Wide-field fundus photograph from neonatal ROP screening. Captured with the Phoenix ICON (100° field of view)
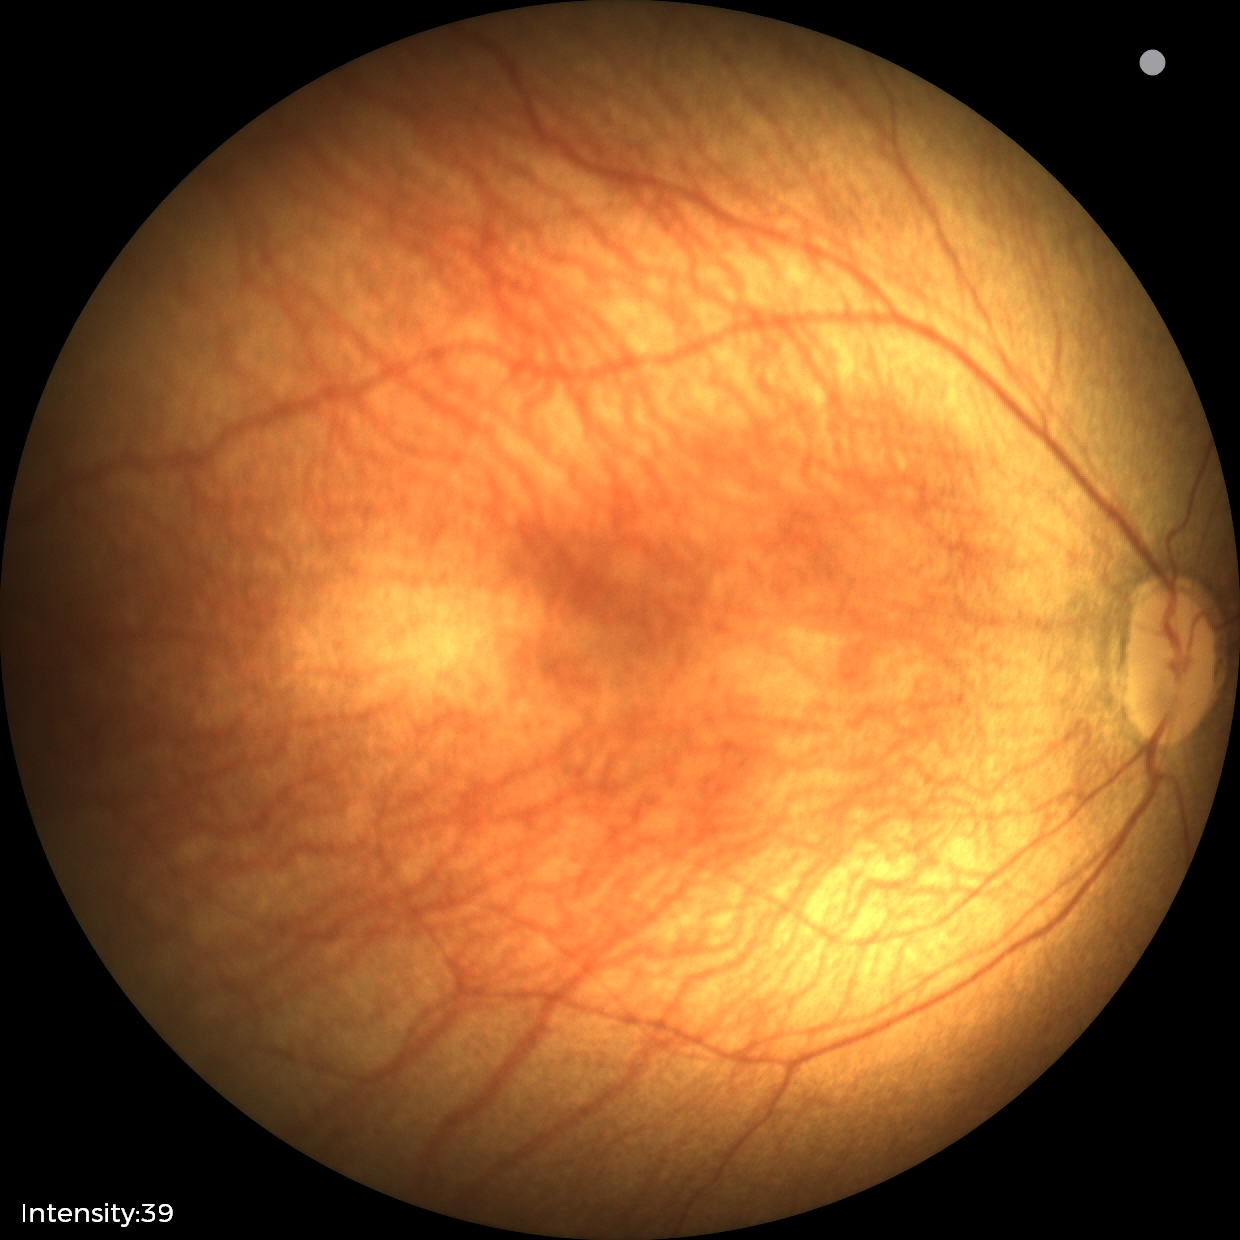 Screening examination diagnosed as physiological.